Wide-field fundus image from infant ROP screening
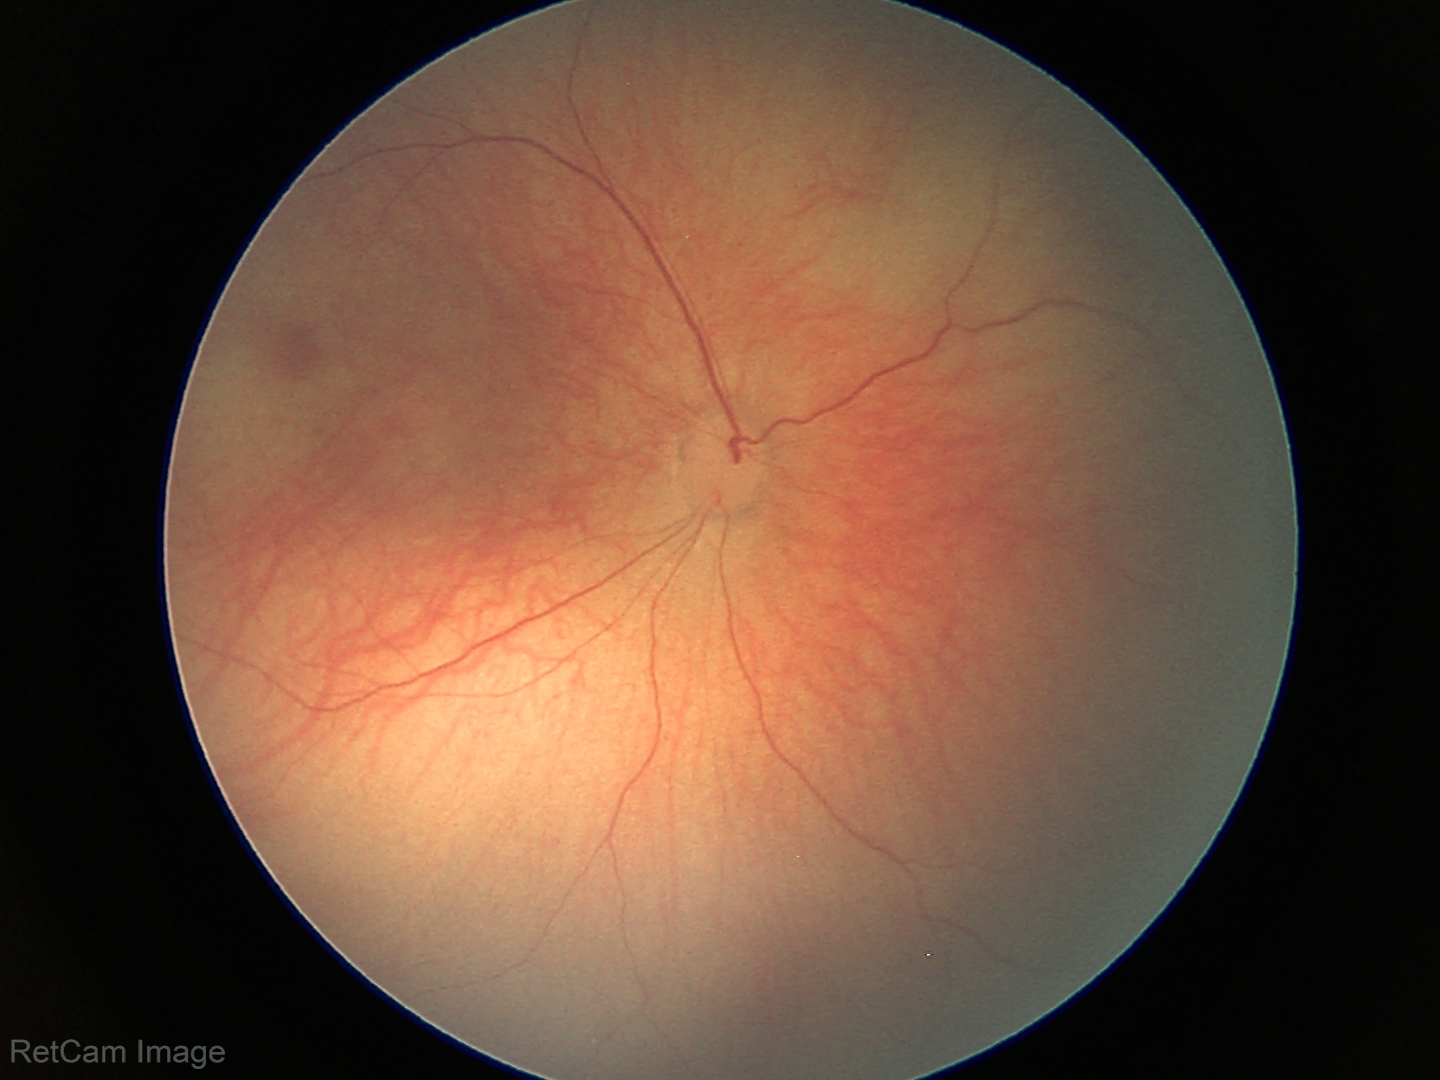 Normal screening examination.